Modified Davis grading · color fundus image: 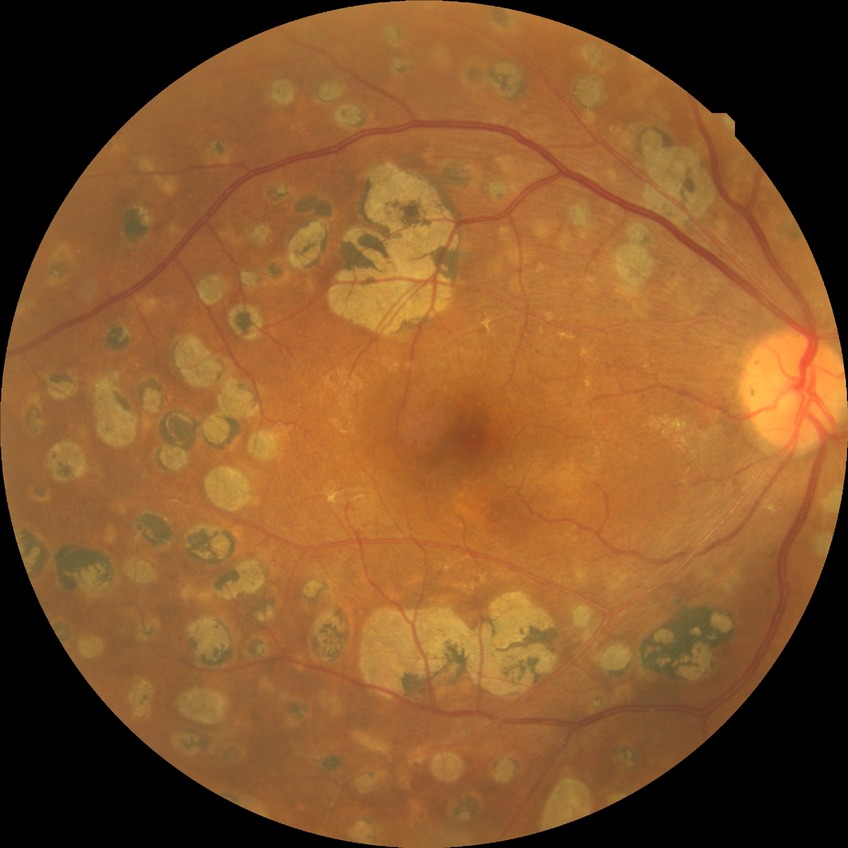
Annotations:
- modified Davis classification — proliferative diabetic retinopathy